Natus RetCam Envision, 130° FOV · pediatric retinal photograph (wide-field)
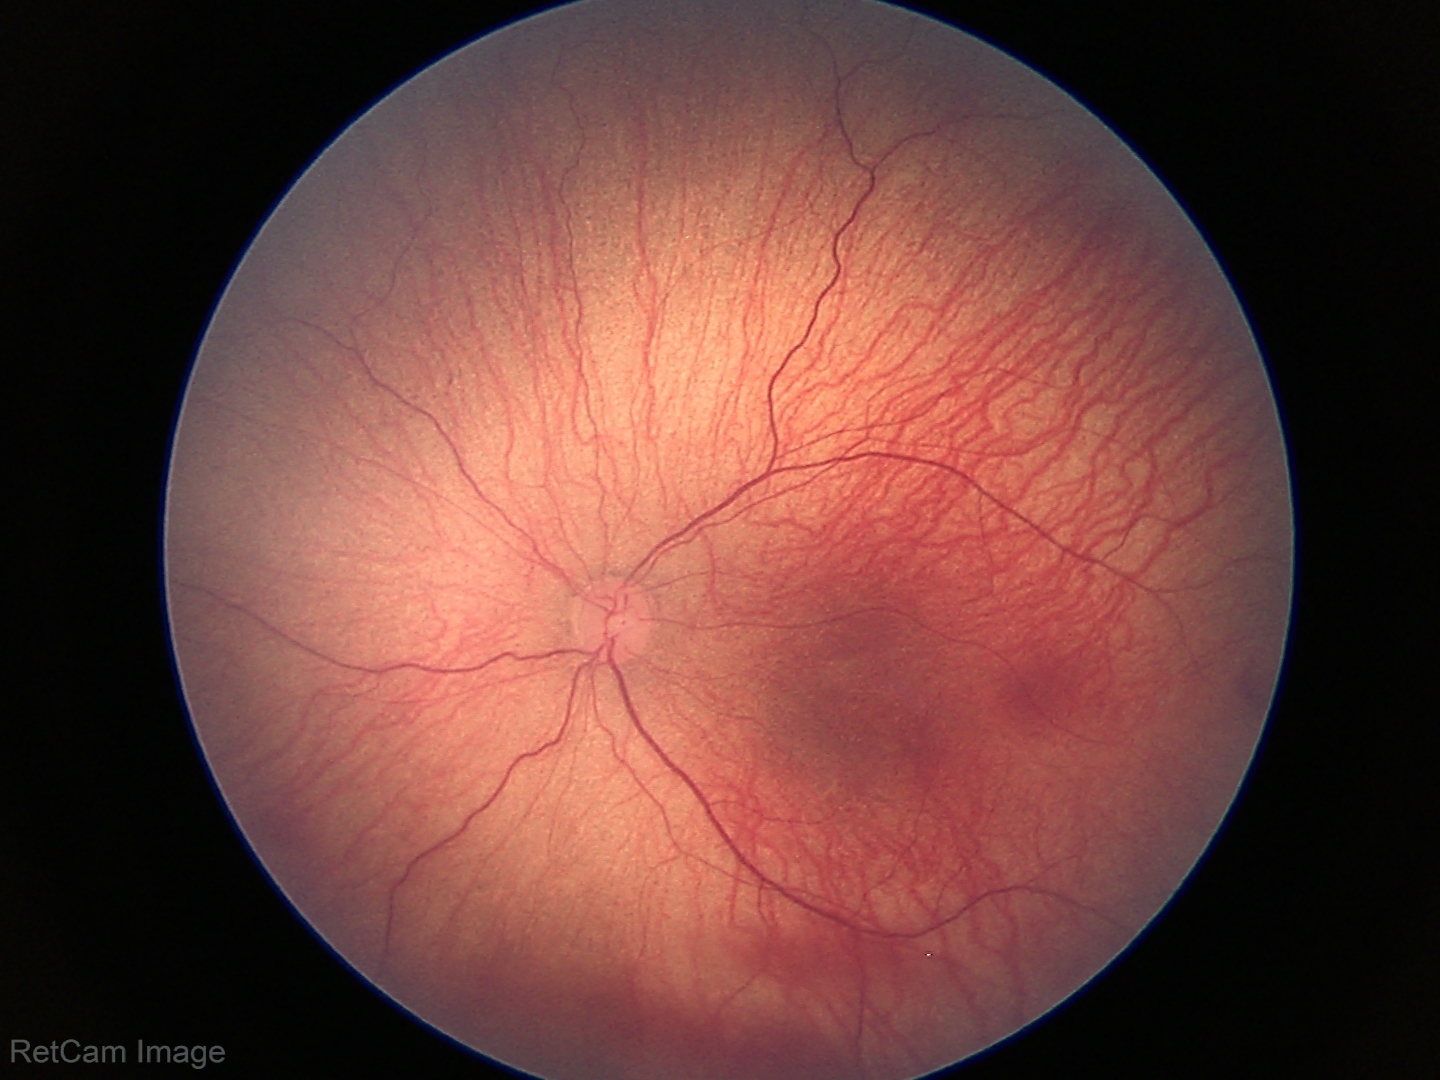

From an examination with diagnosis of retinopathy of prematurity (ROP) stage 1.